Modified Davis classification — 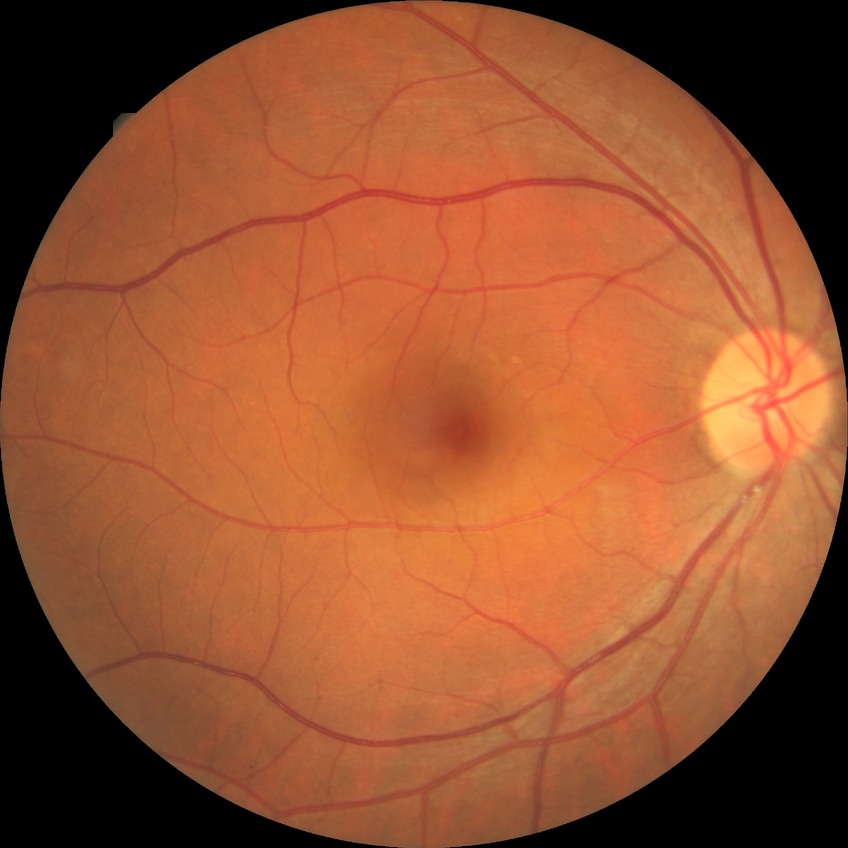 Davis stage: SDR.